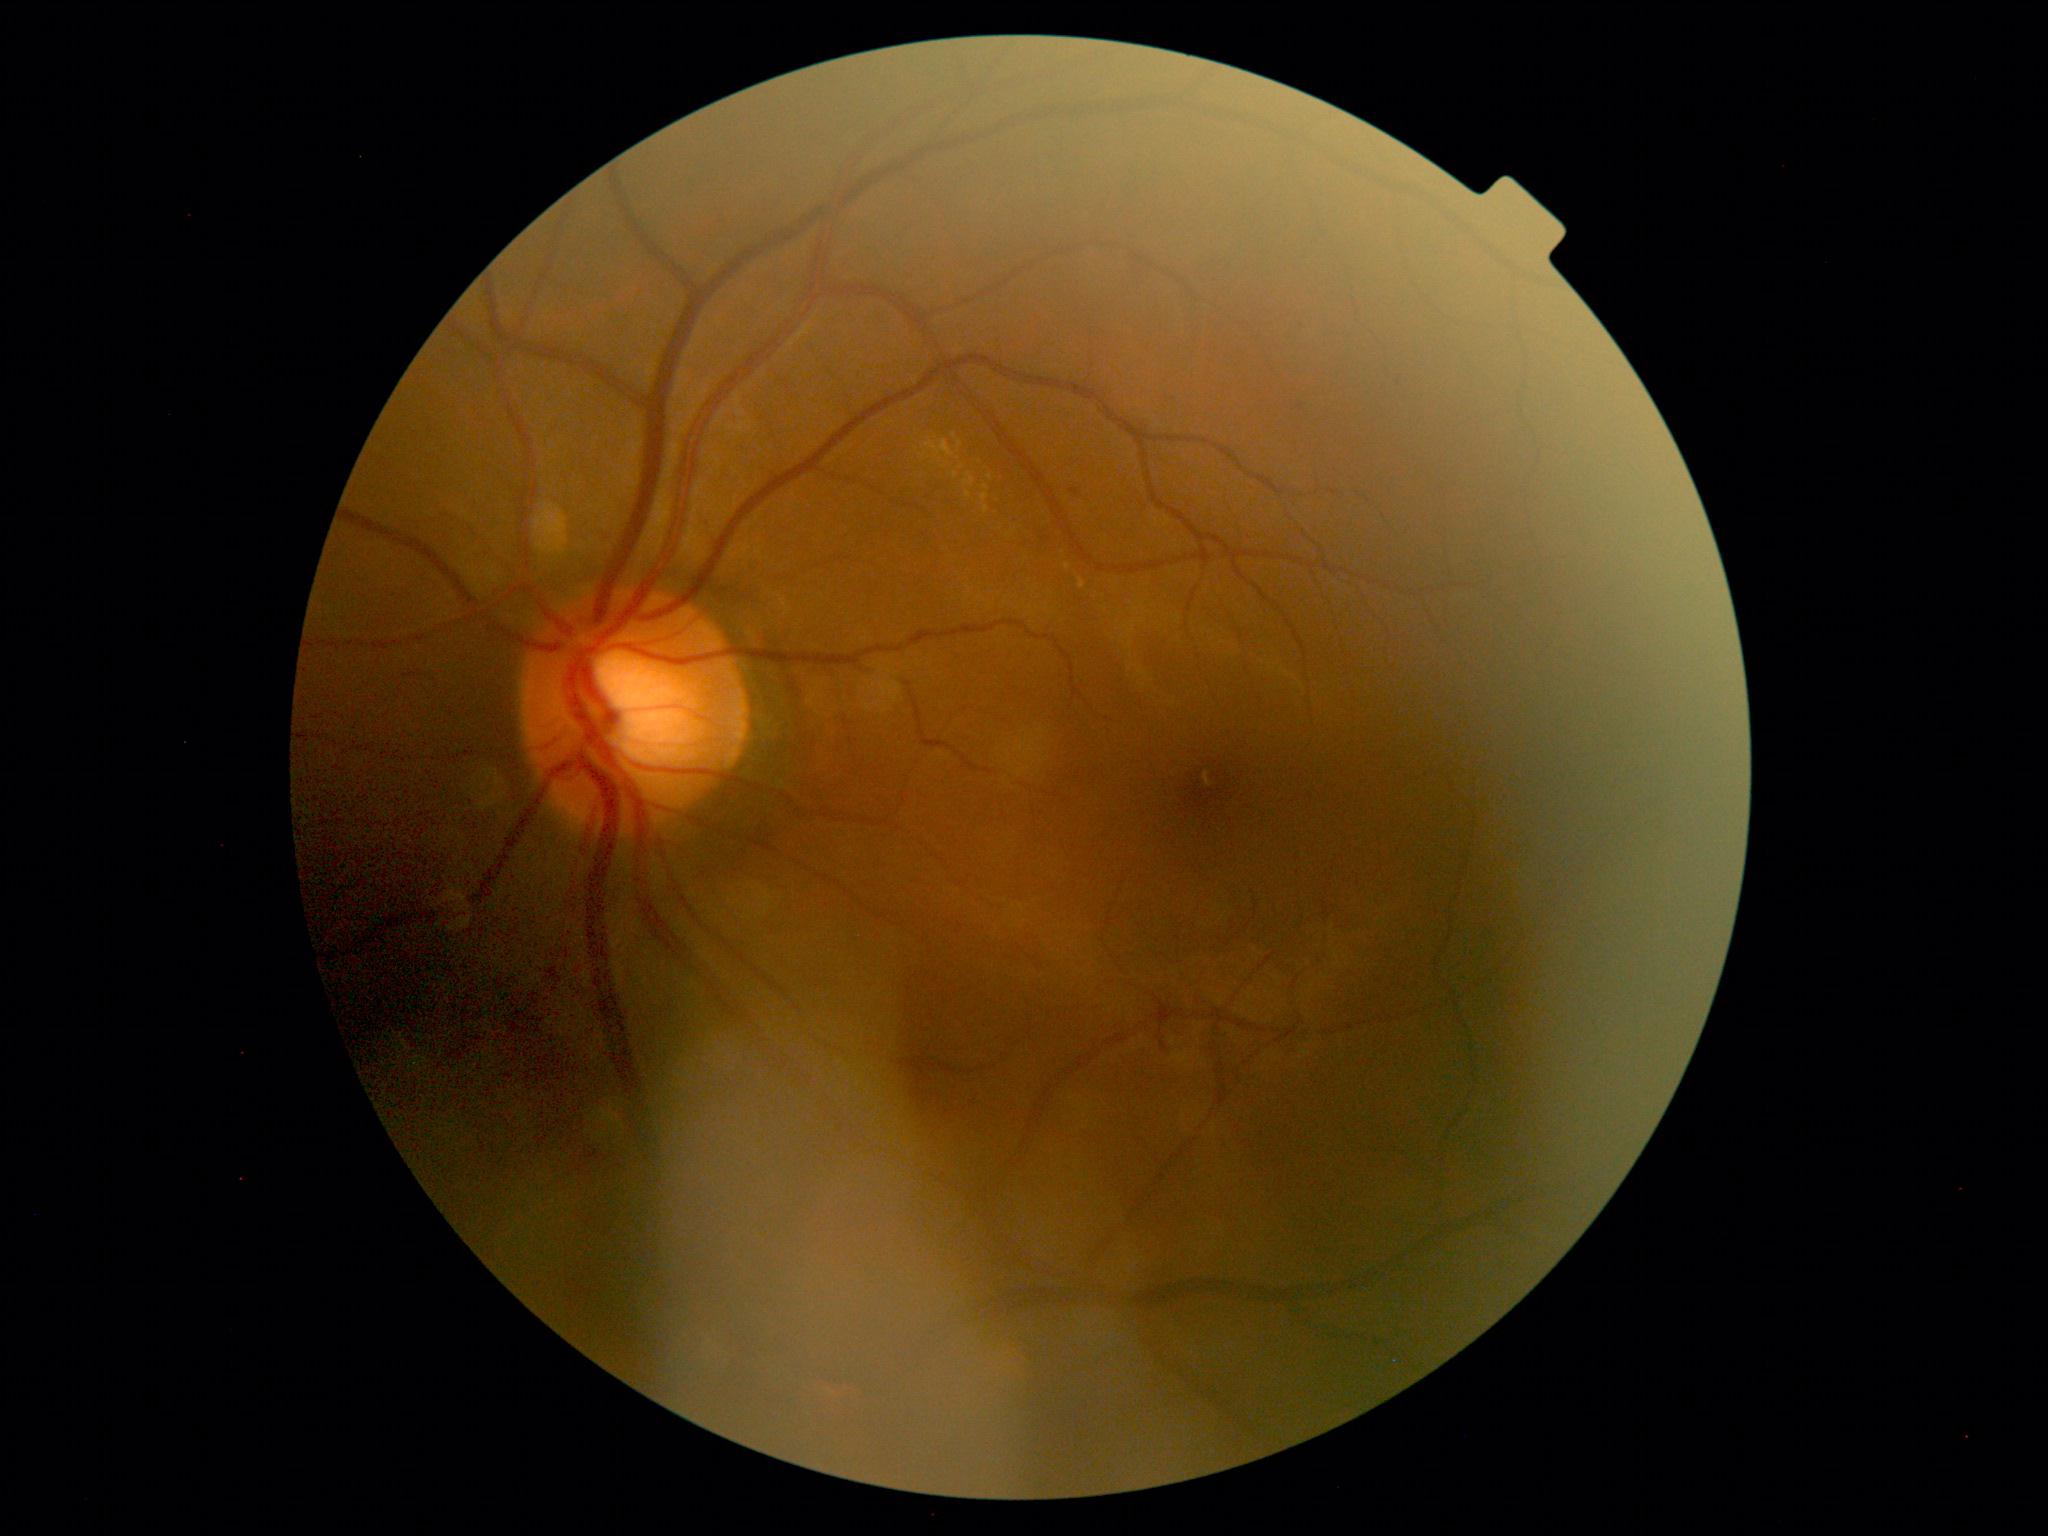

DR grade: 2/4.